848x848px; NIDEK AFC-230; color fundus image
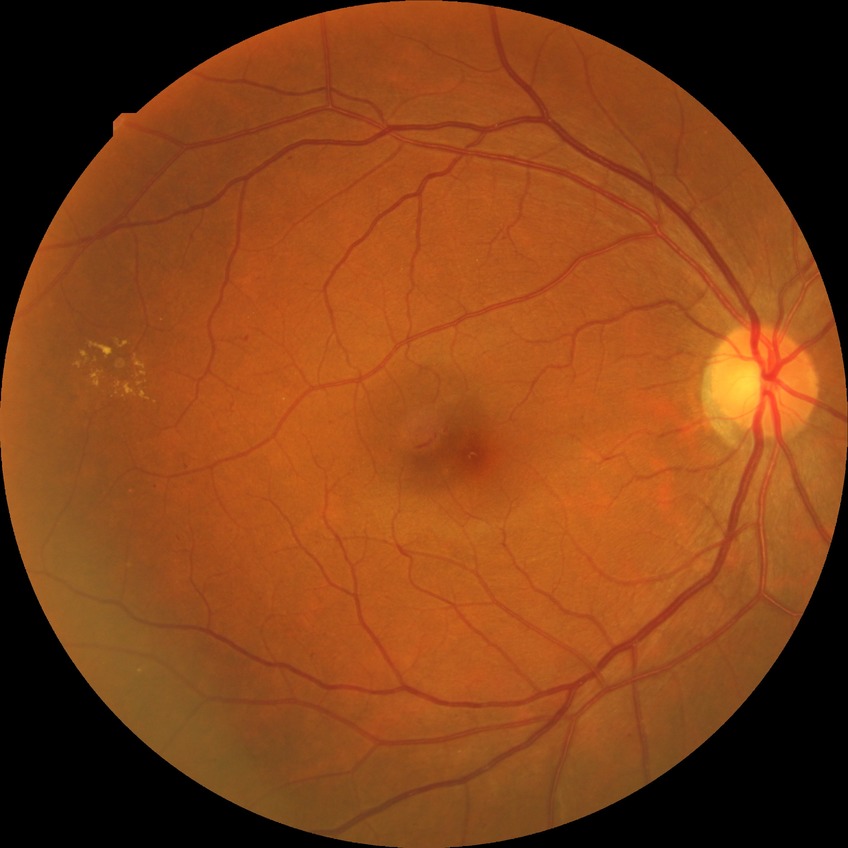
DR grade is SDR.